Pediatric wide-field fundus photograph
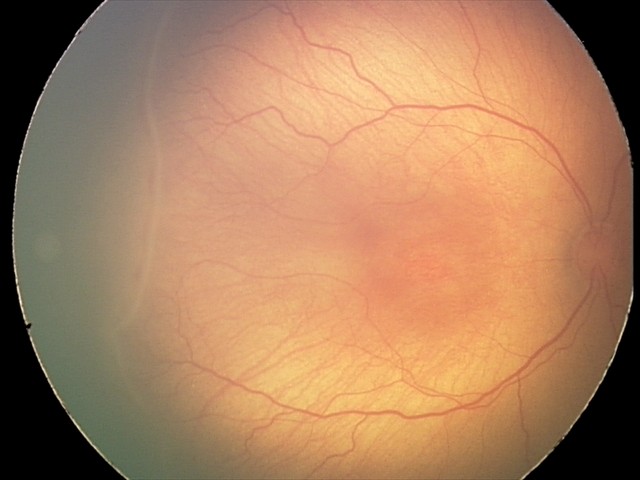
Plus disease = absent
finding = retinopathy of prematurity stage 2